240x240
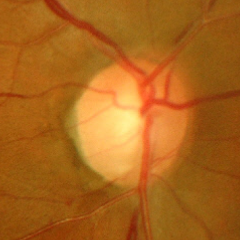

Q: What stage of glaucoma is present?
A: Yes — advanced-stage glaucoma. (Criteria: near-total cupping of the optic nerve head, with or without severe visual field loss within the central 10 degrees of fixation.)